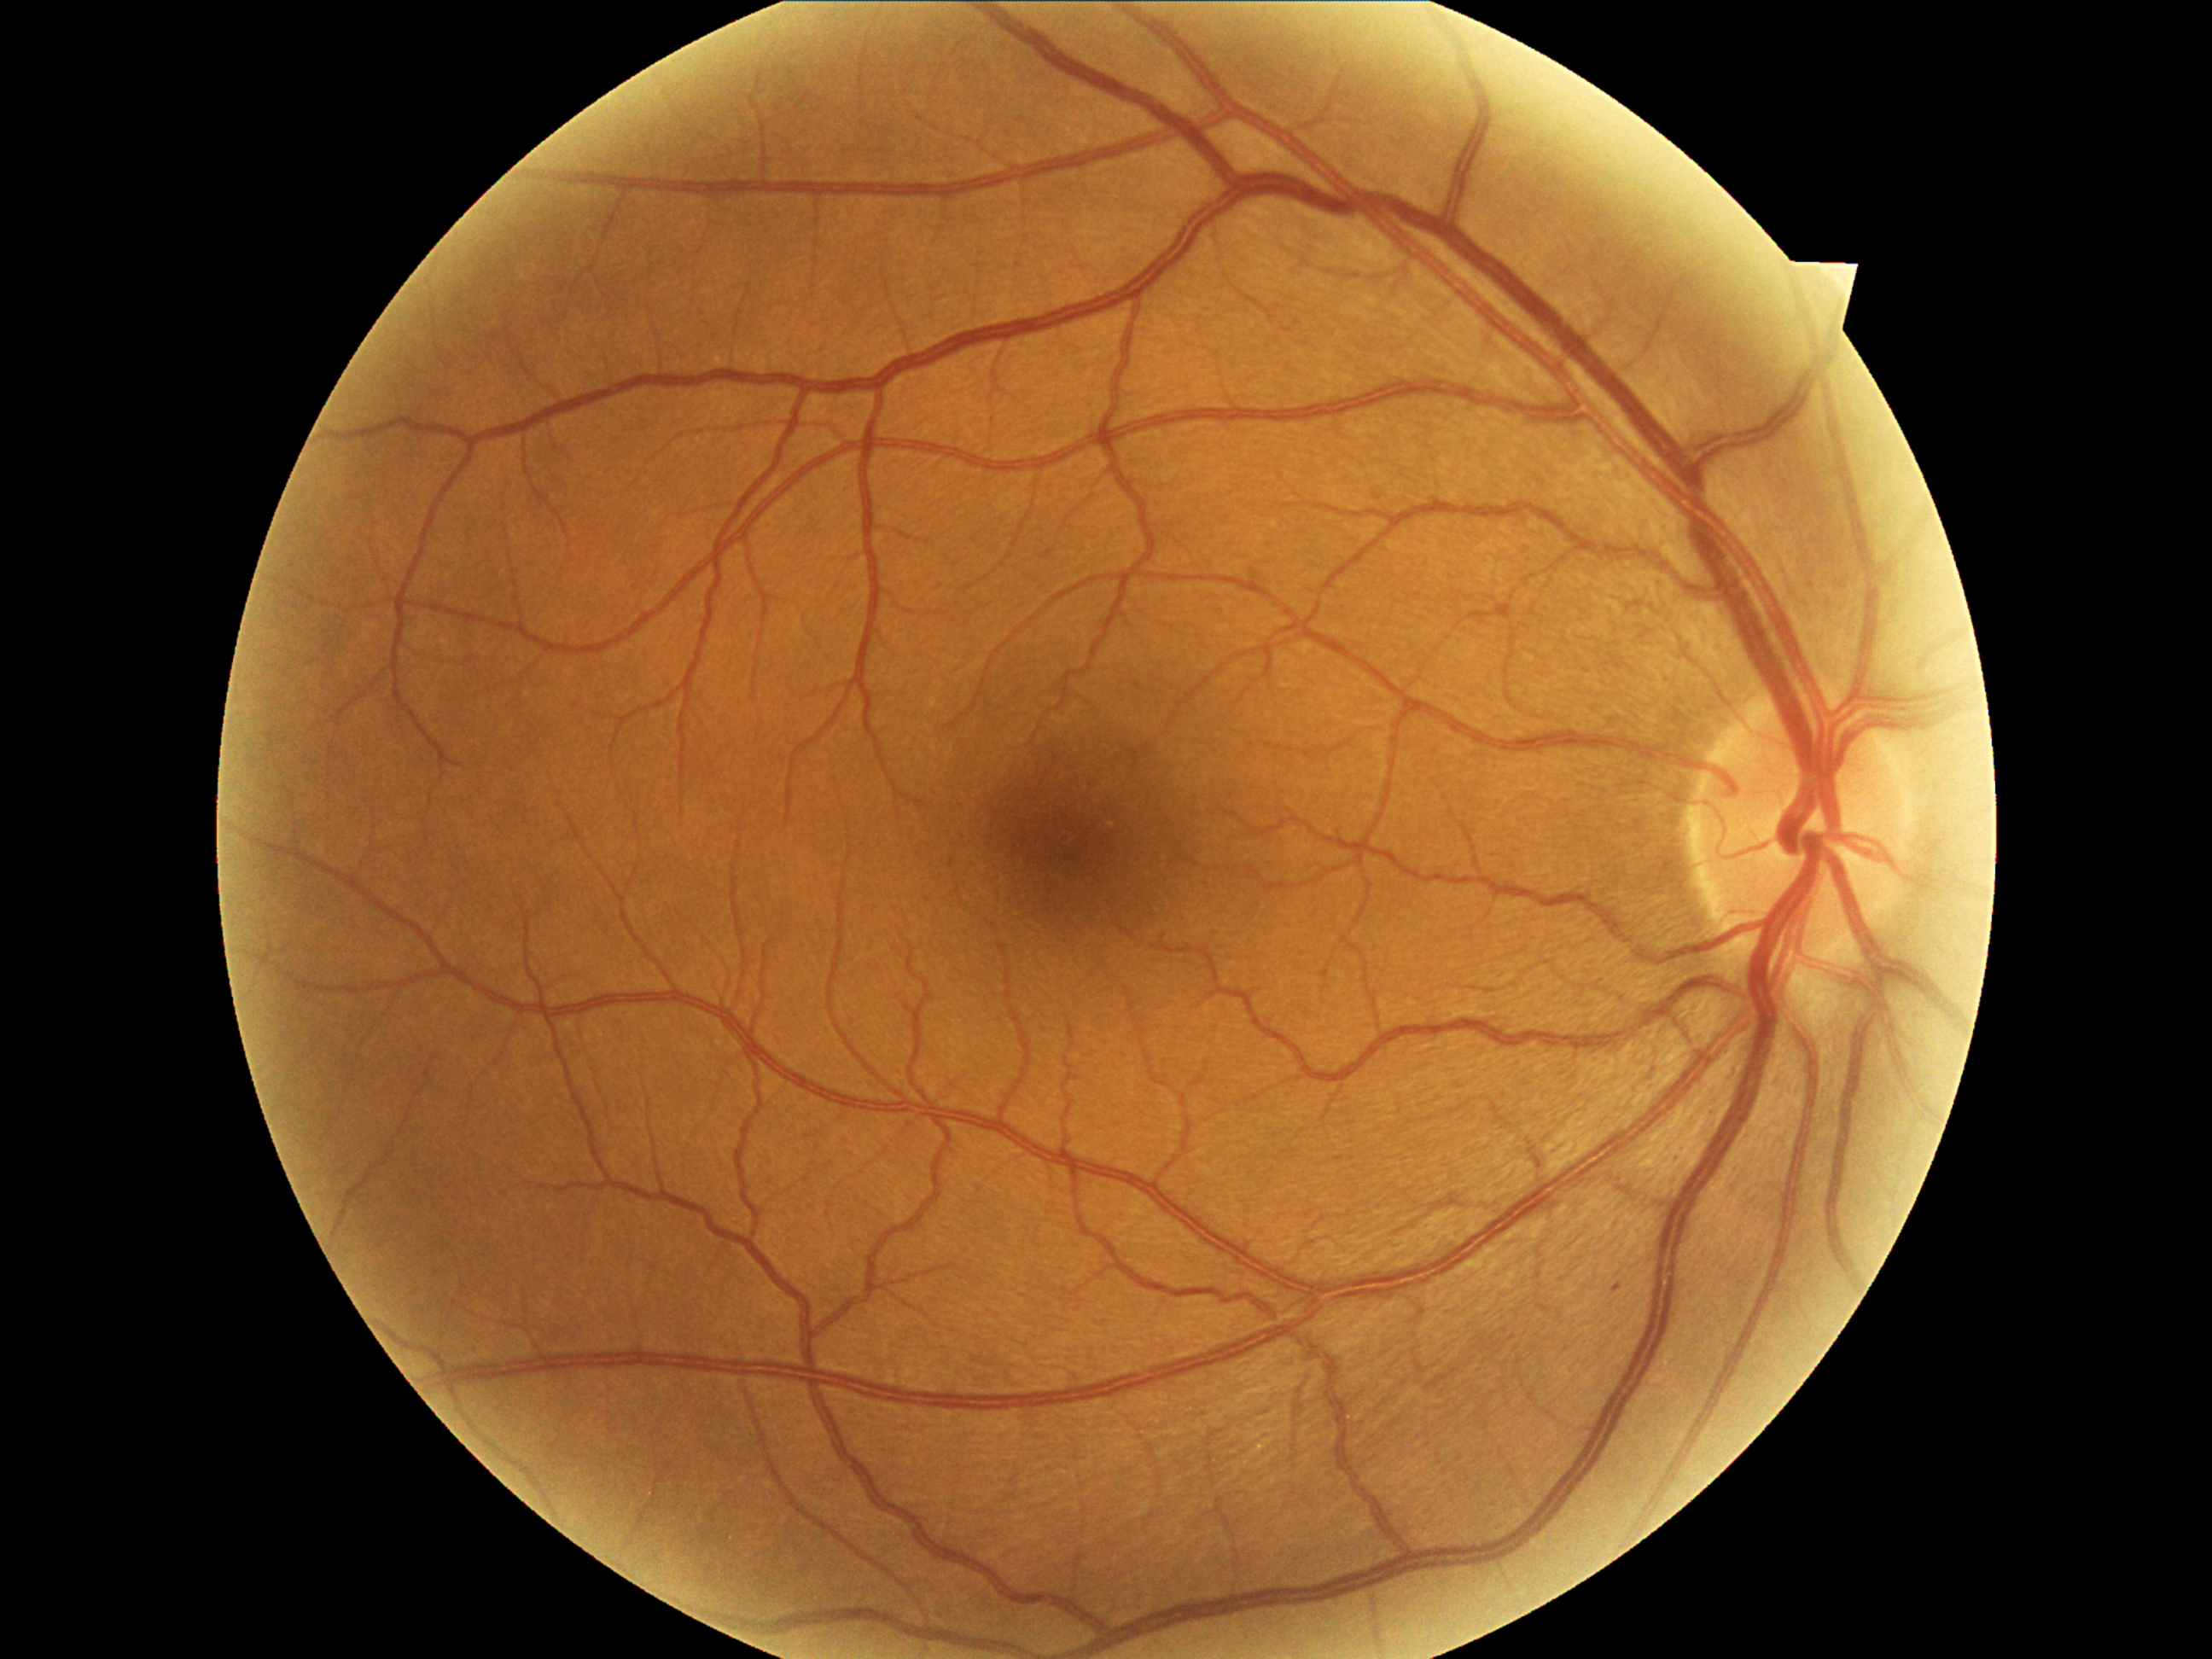
Diabetic retinopathy (DR) is 1/4 — presence of microaneurysms only
soft exudates (SEs): absent
hemorrhages (HEs): absent
hard exudates (EXs): absent
microaneurysms (MAs): left=1614, top=1284, right=1622, bottom=1293
Small MAs approximately at [1567,1349]